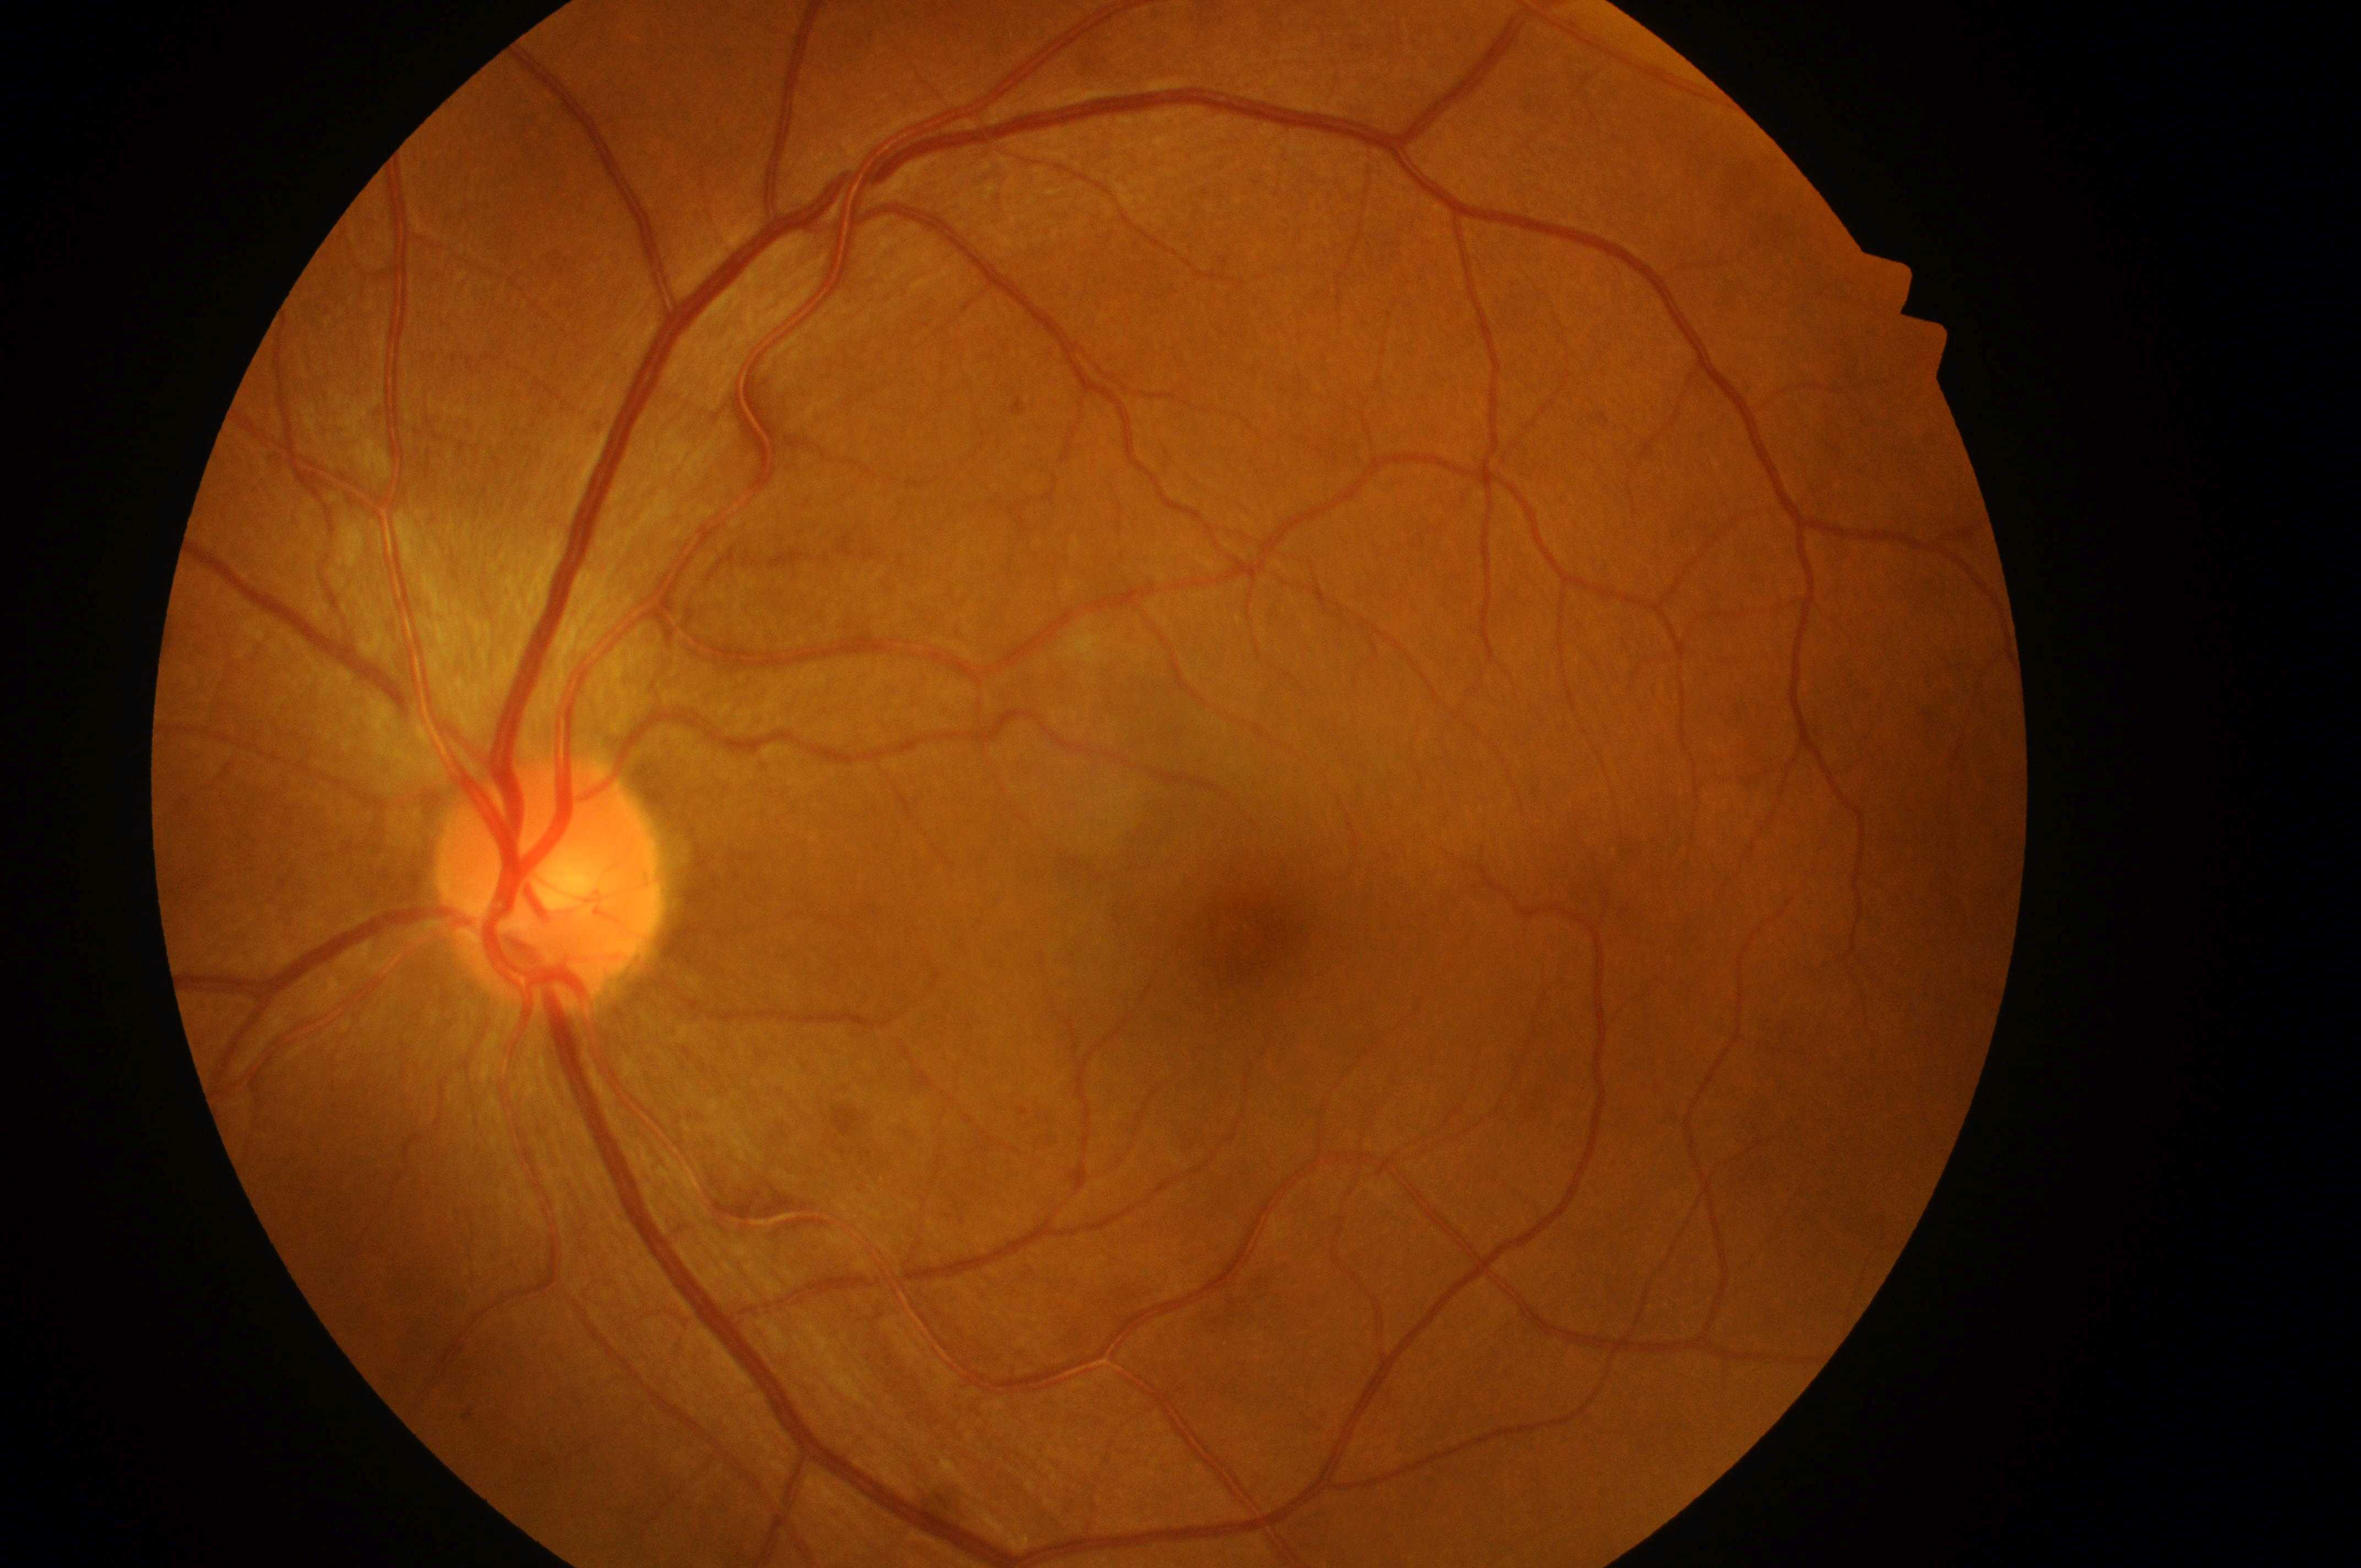
Diabetic macular edema (DME): grade 0 — no apparent hard exudates. Disc center located at (546,886). Diabetic retinopathy (DR): 1 — presence of microaneurysms only. Eye: the left eye. Foveal center: (1252,934).